Retinal fundus photograph · 1932 x 1932 pixels · FOV: 50 degrees:
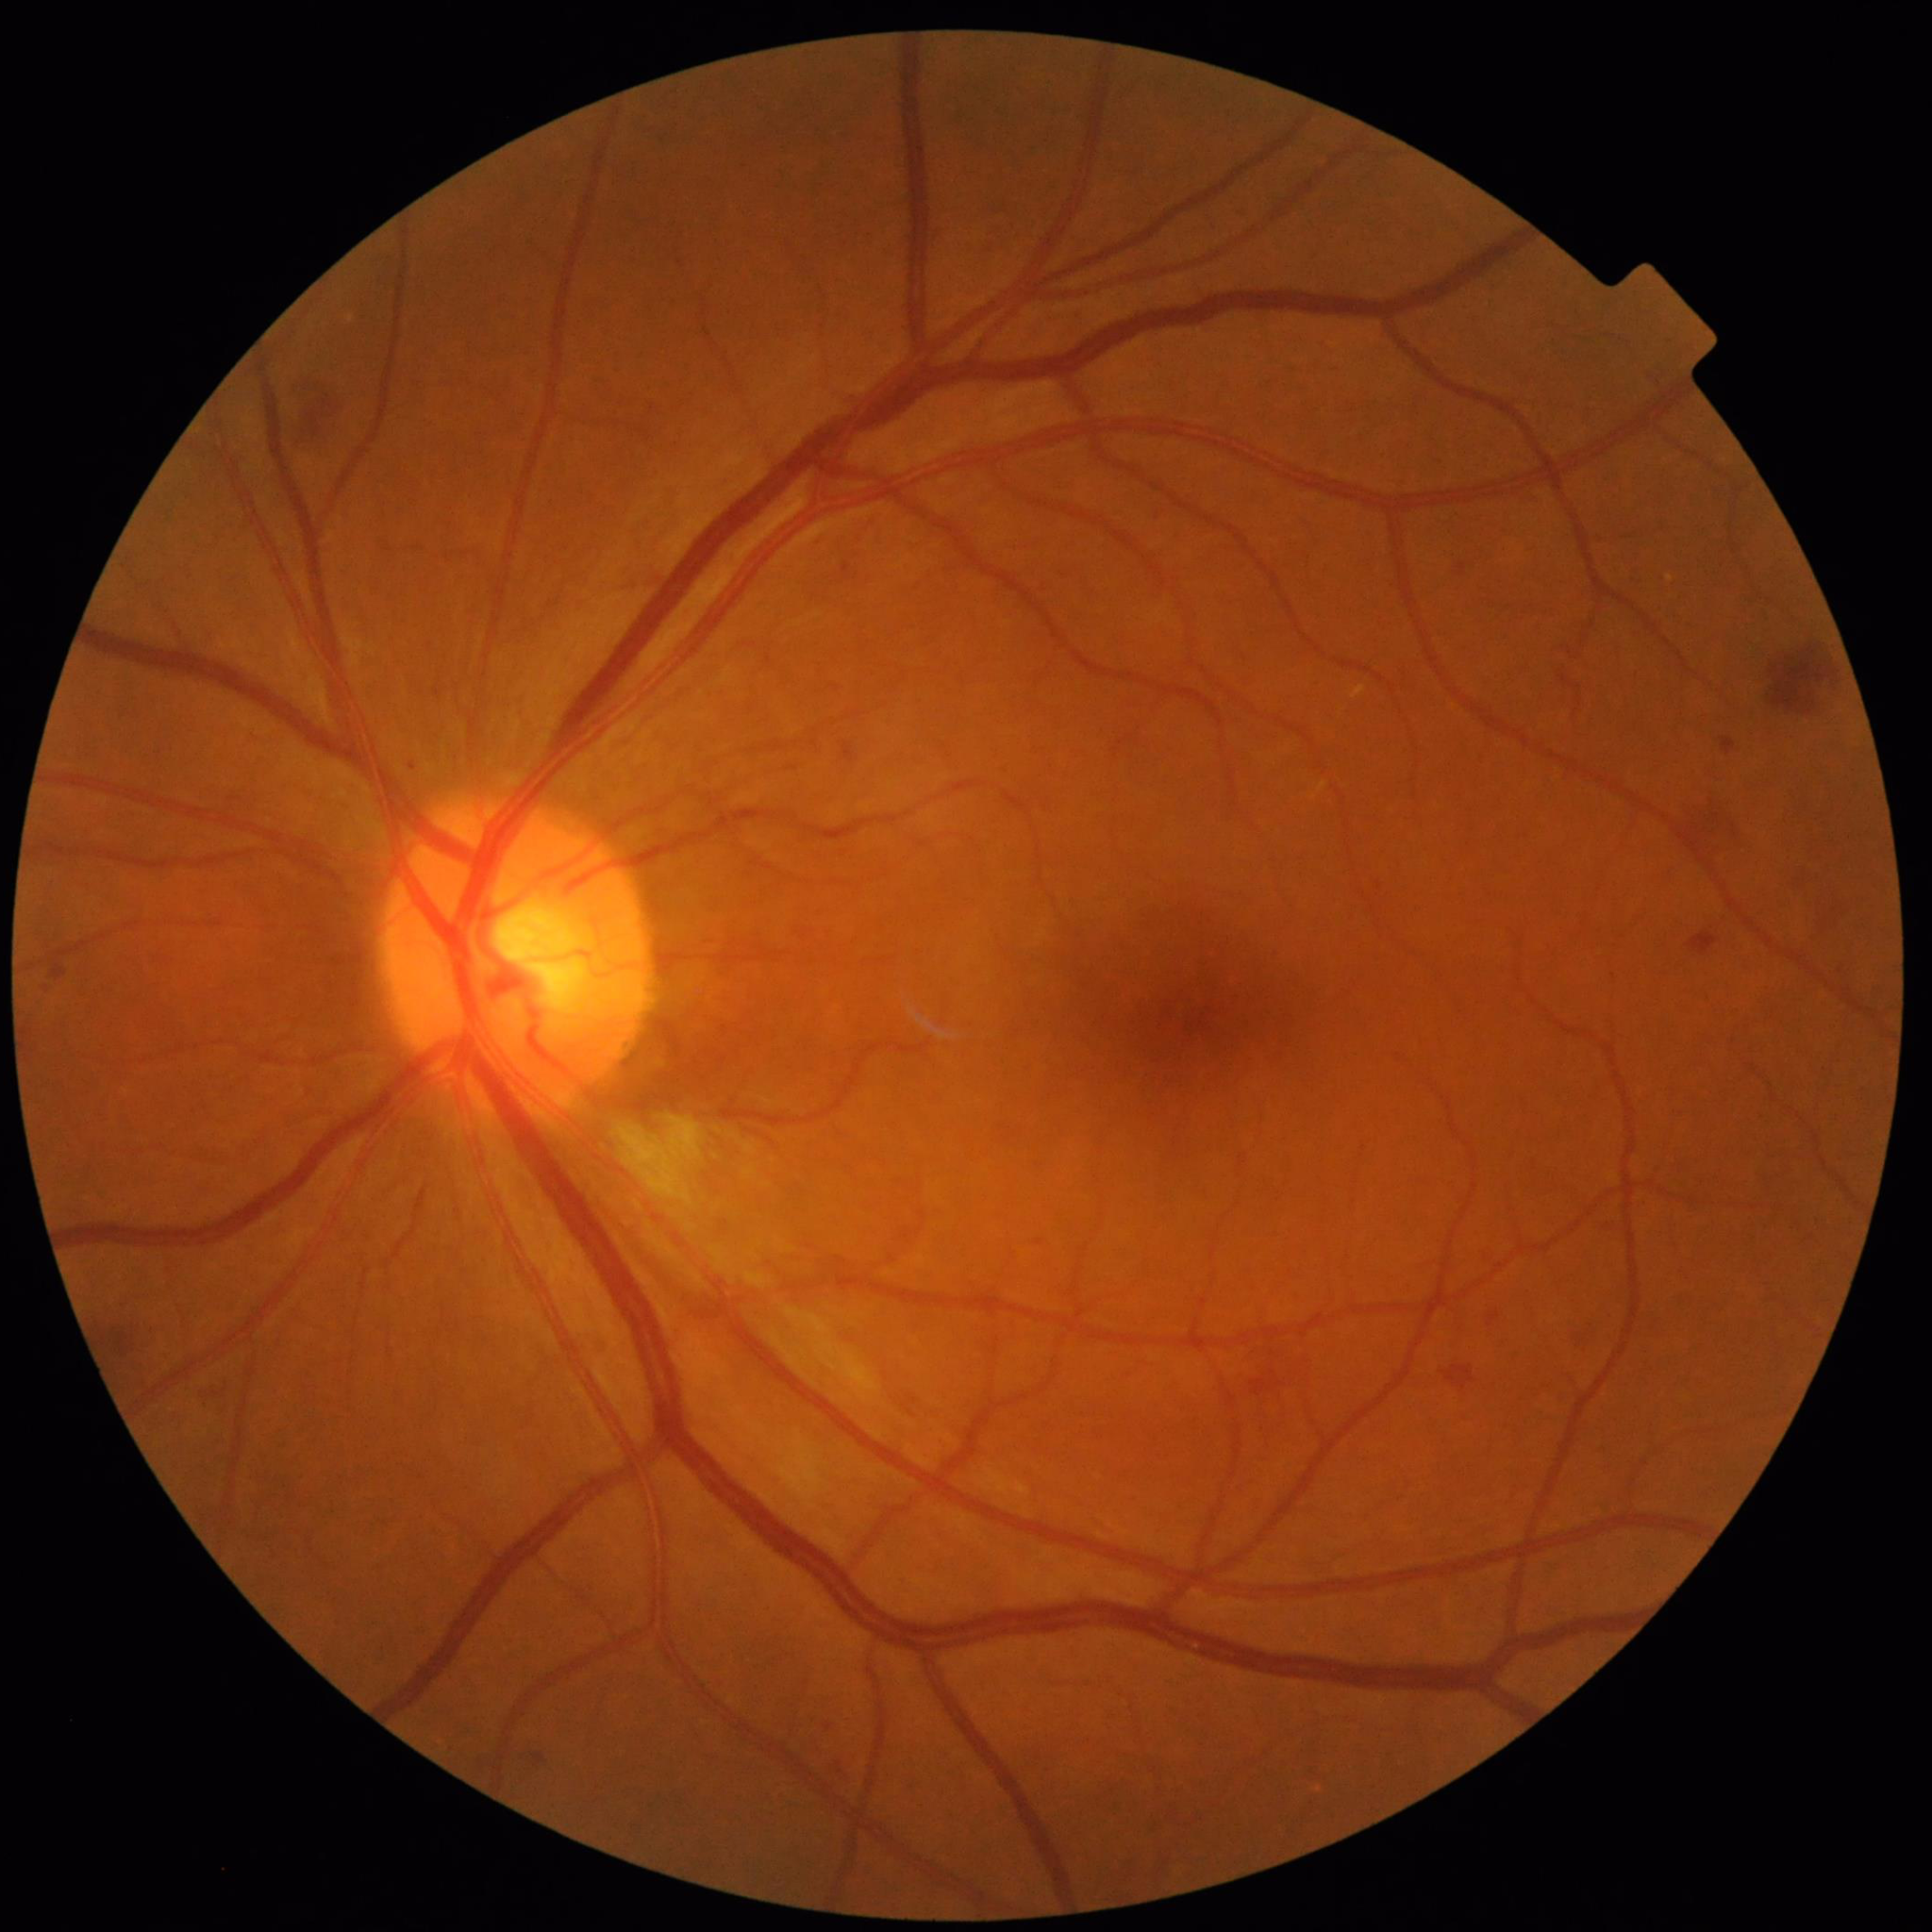 Patient diagnosed with diabetic retinopathy.